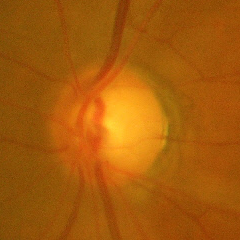
Glaucomatous optic neuropathy is present. Glaucoma diagnosis: severe glaucomatous damage.